1240 by 1240 pixels; wide-field fundus image from infant ROP screening: 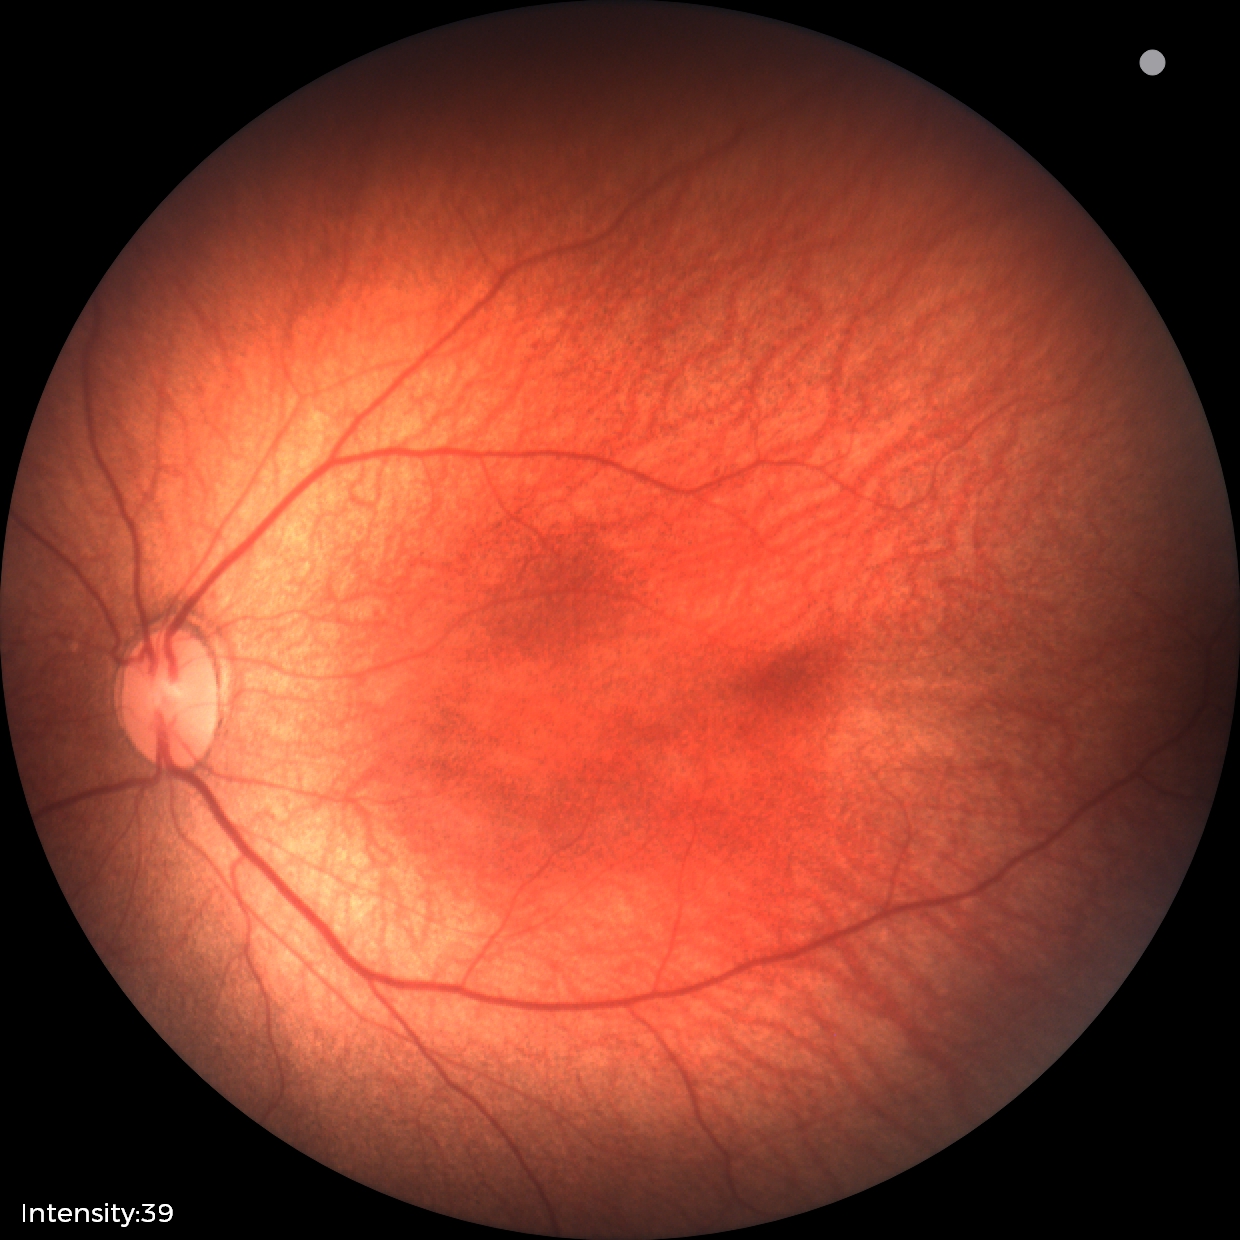 No plus disease. Diagnosis from this screening exam: status post ROP.